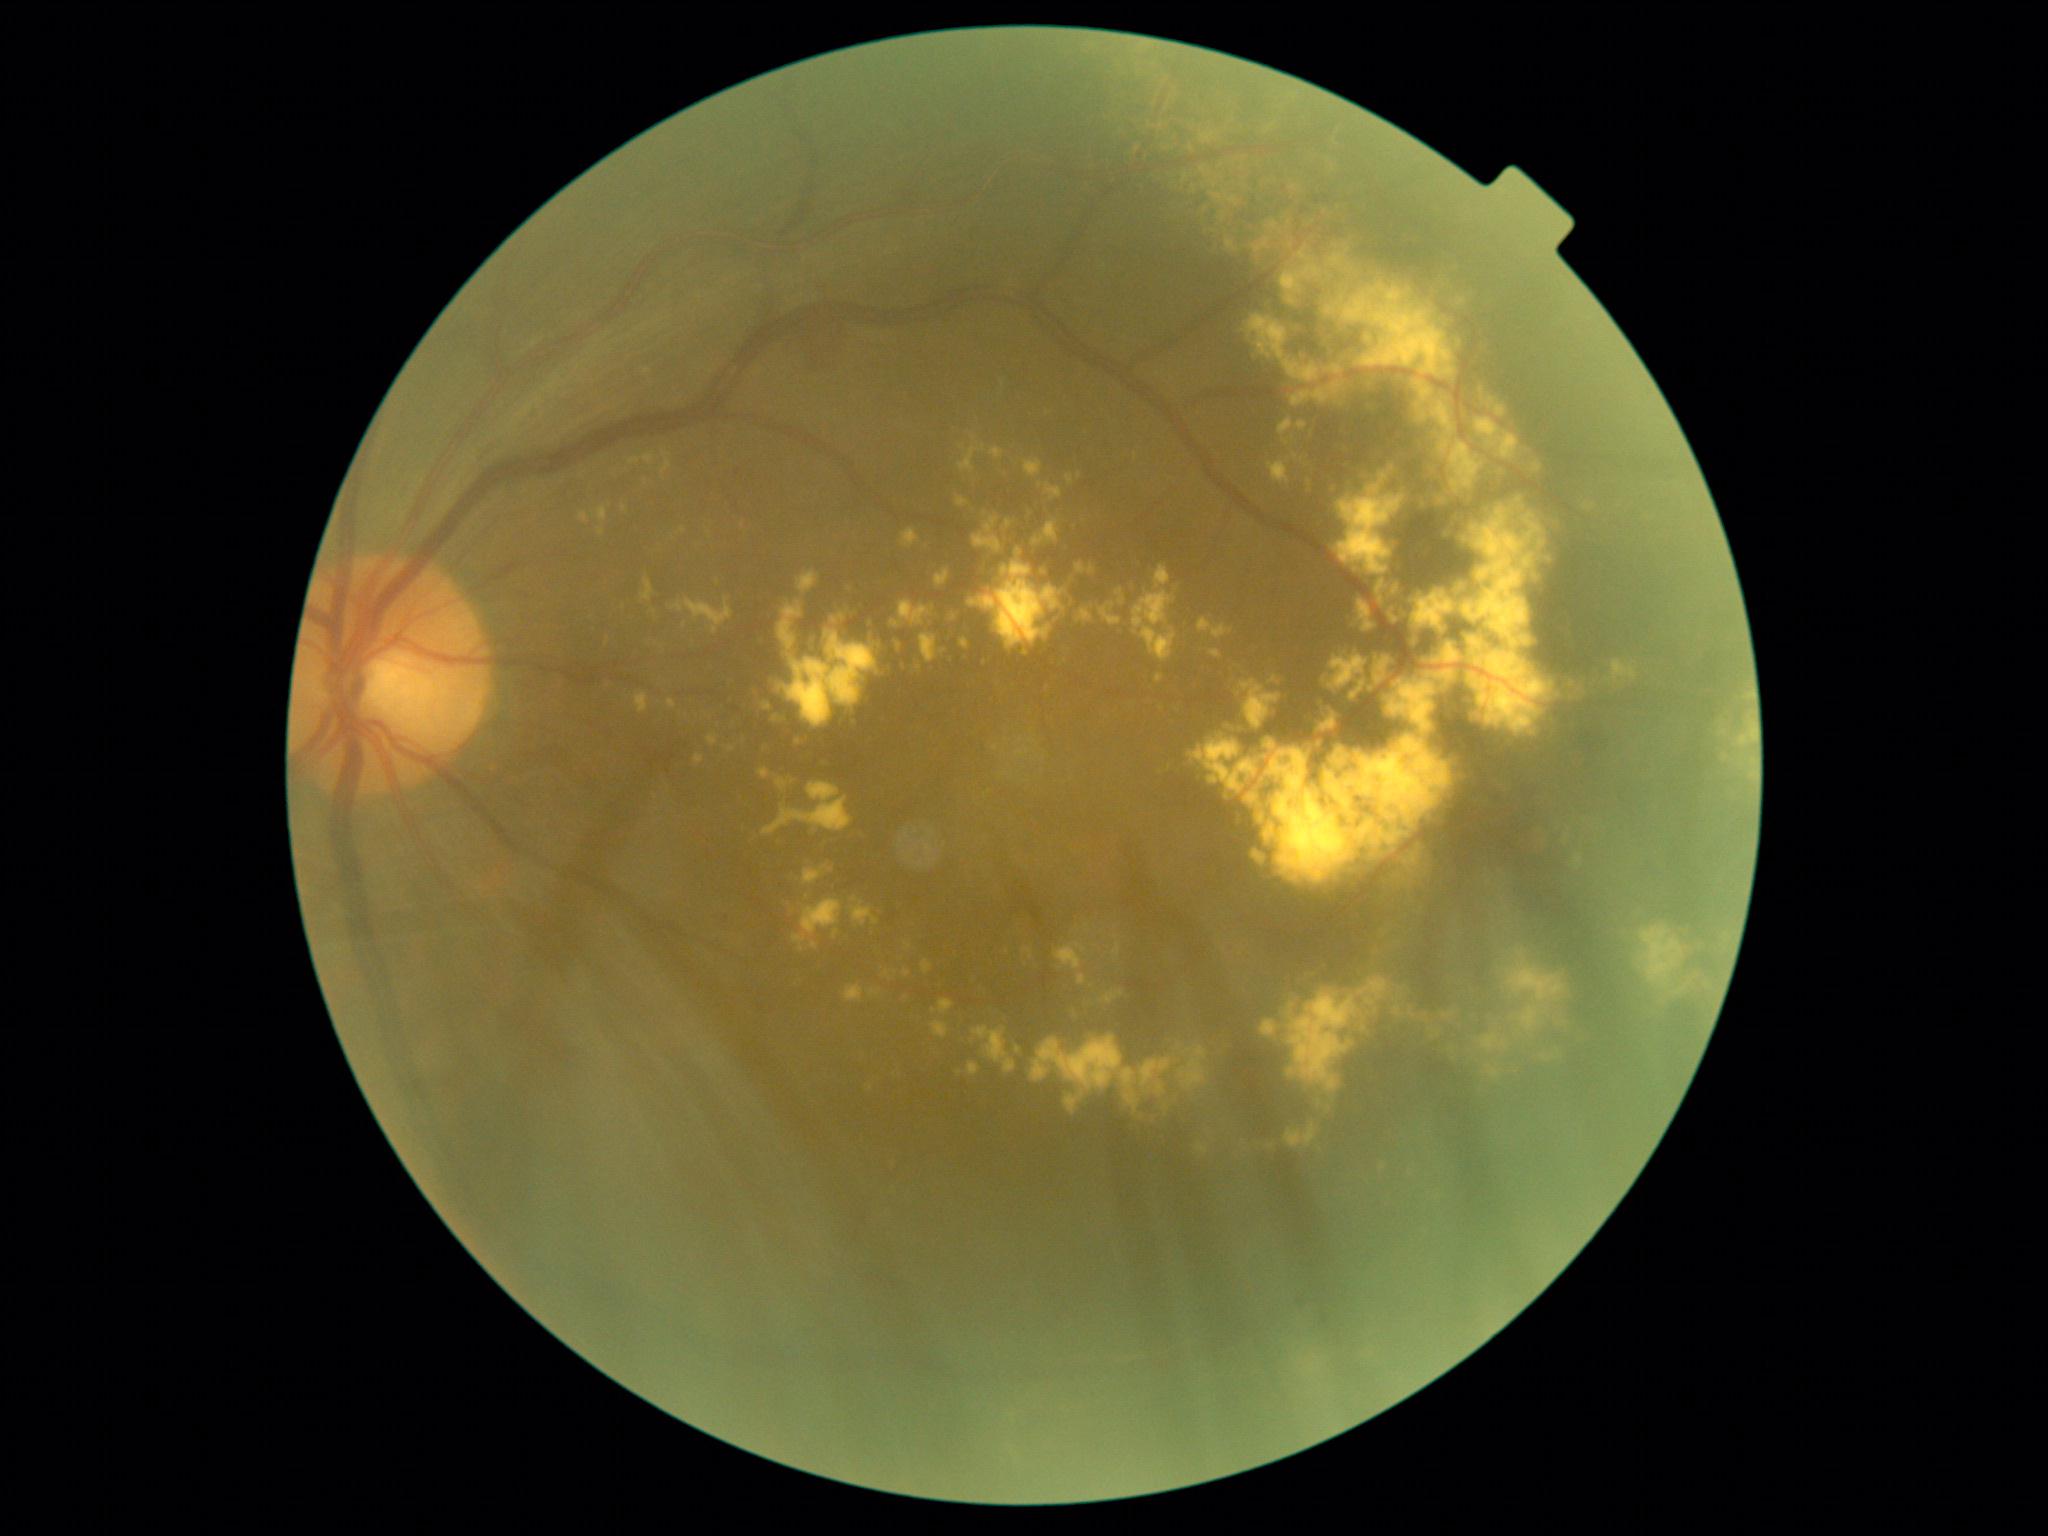
diabetic retinopathy (DR): moderate NPDR (grade 2).